NIDEK AFC-230. Modified Davis grading. Image size 848x848
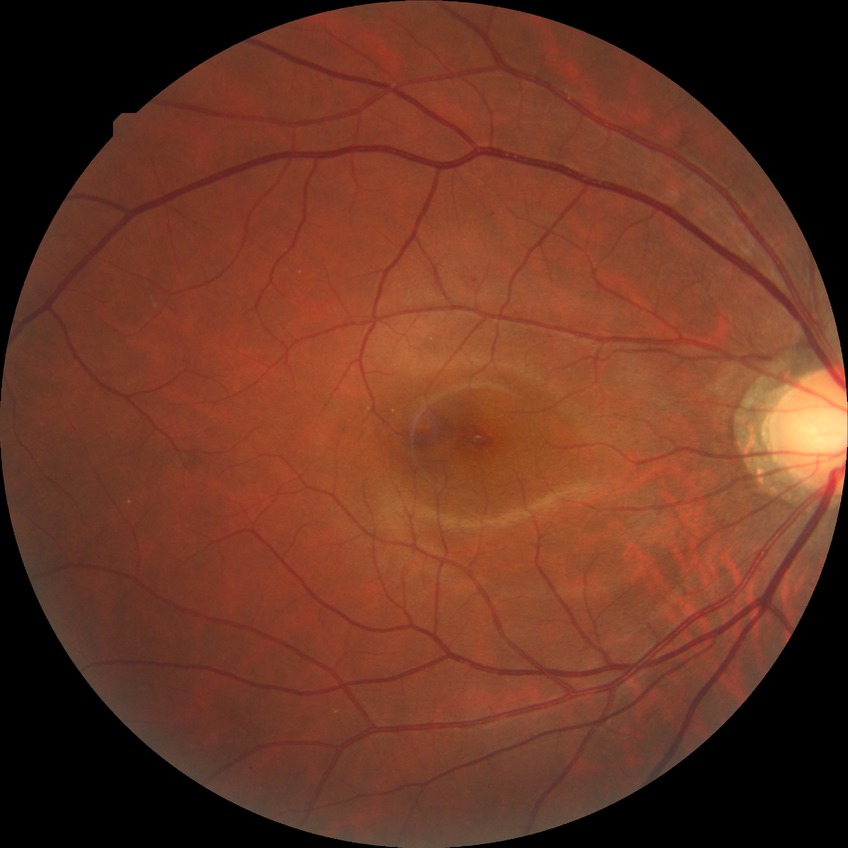

Retinopathy grade is simple diabetic retinopathy.